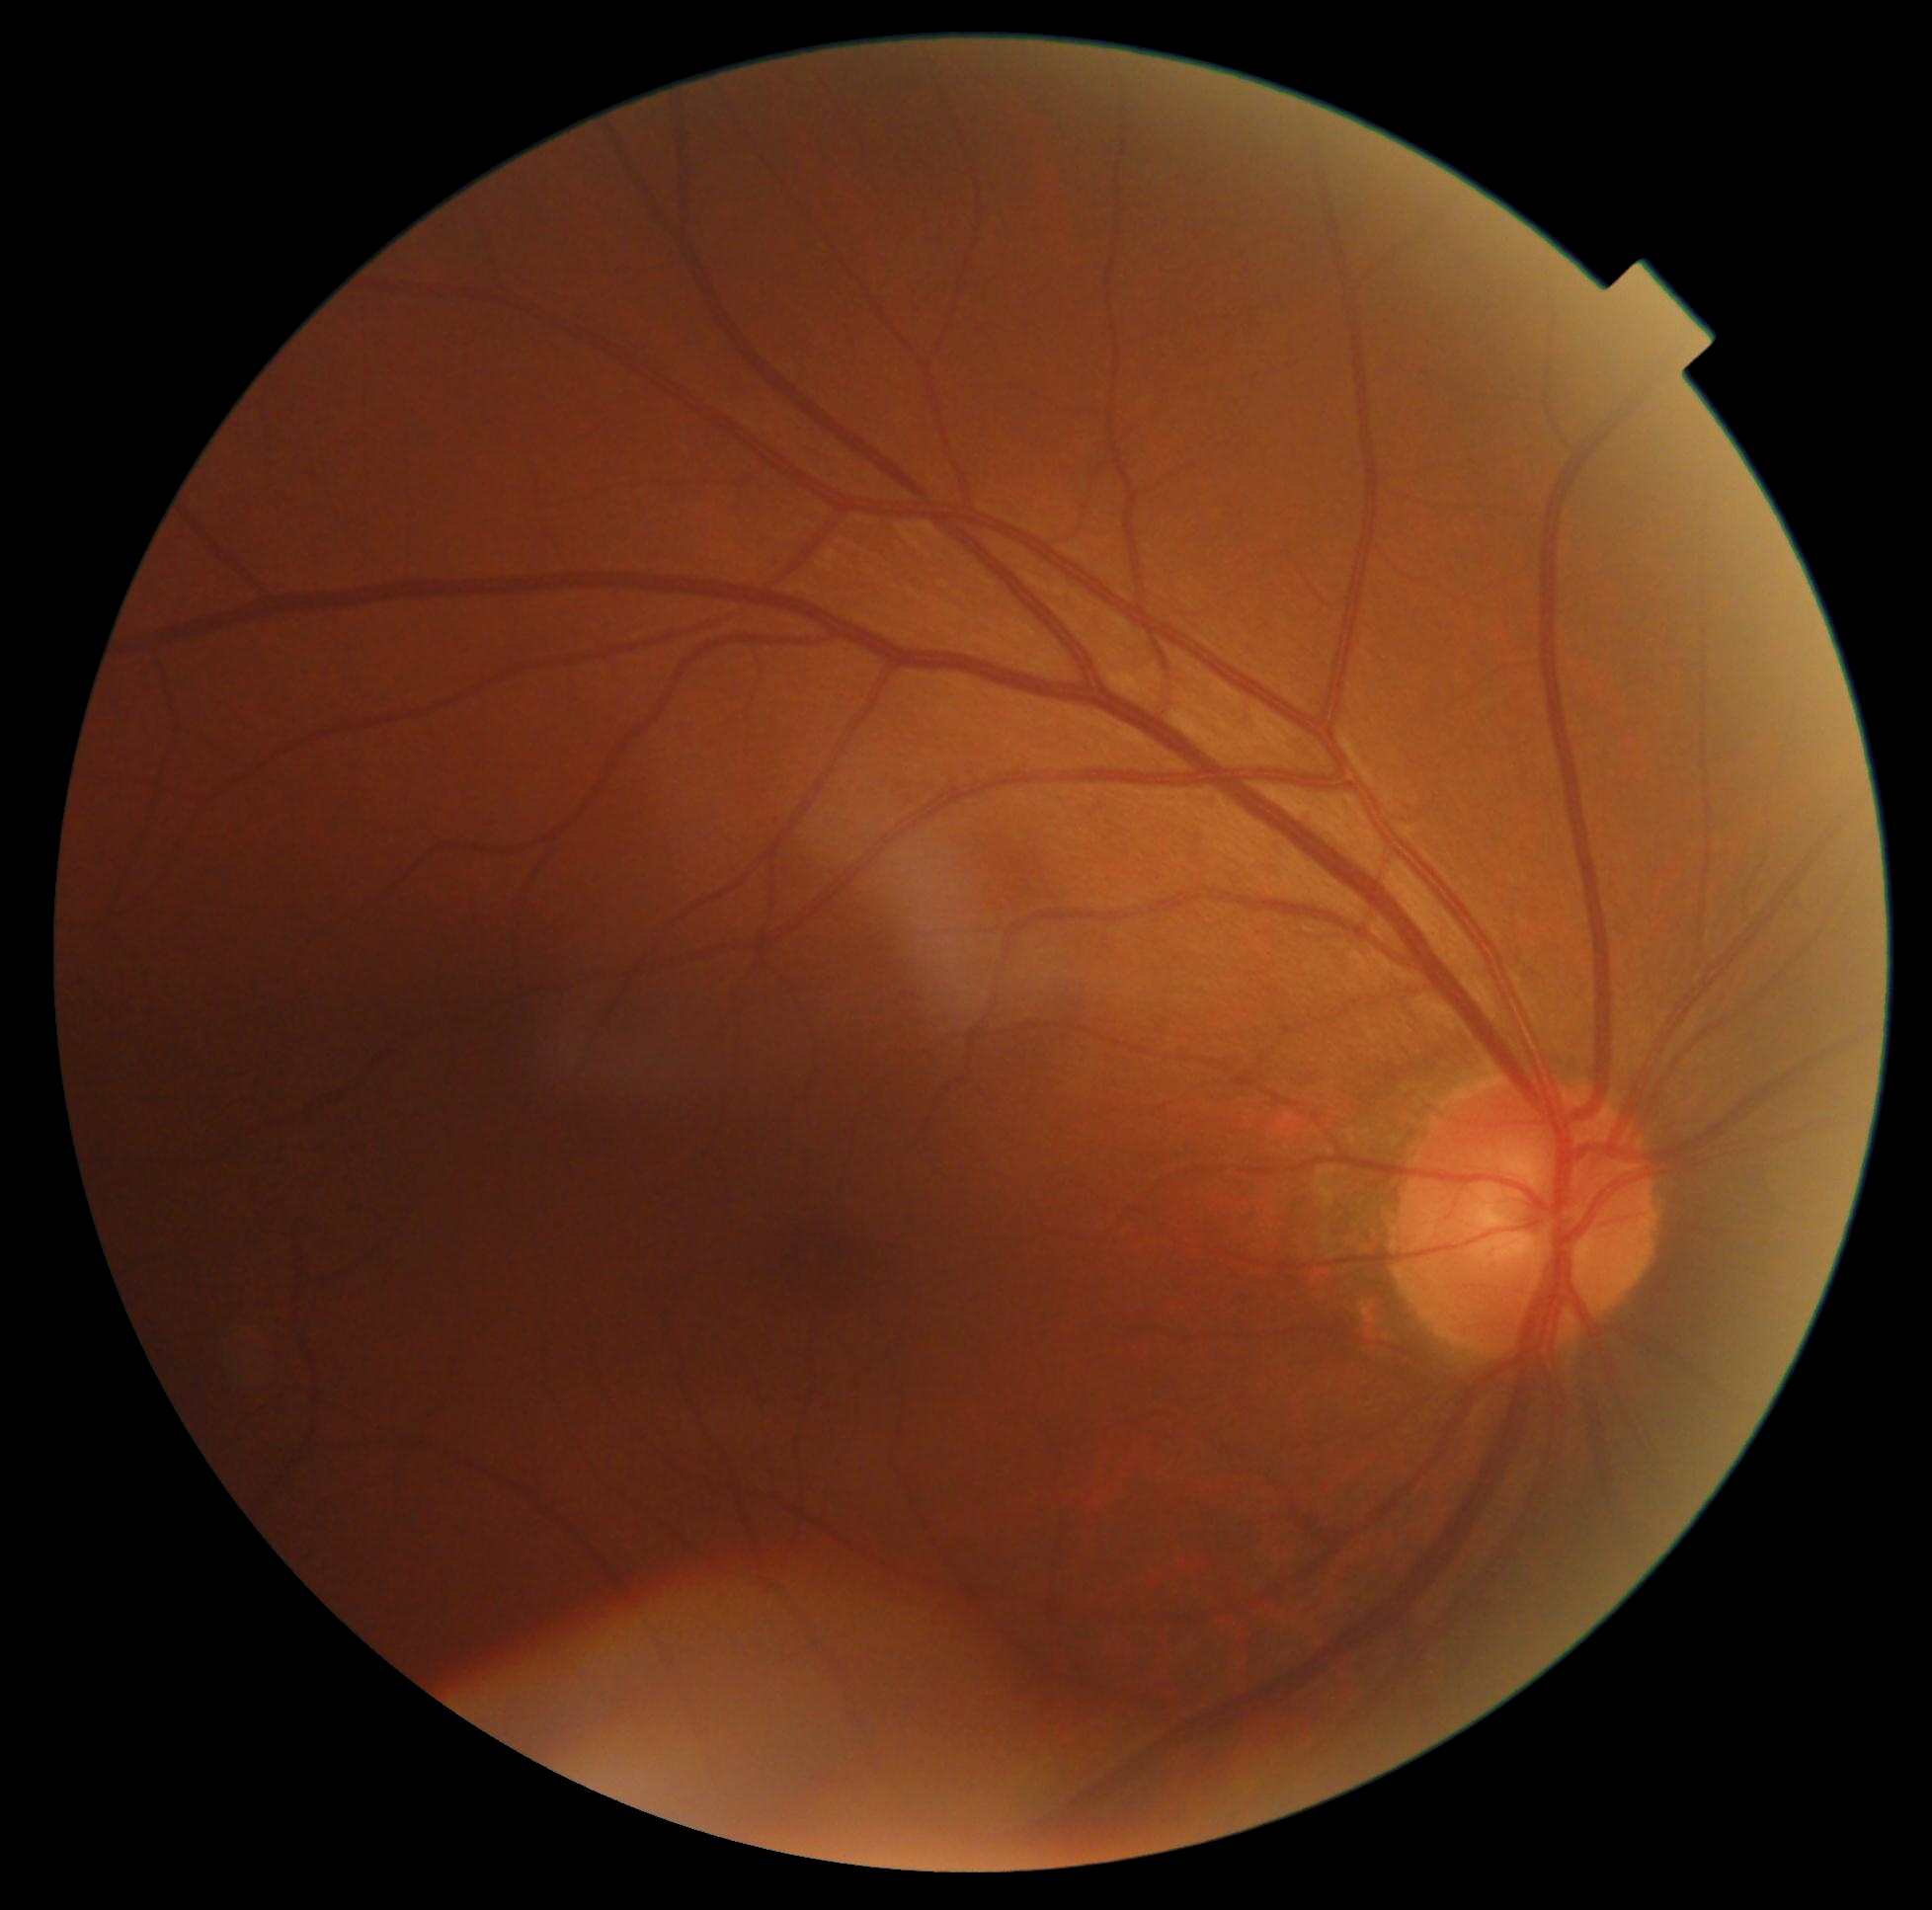 Findings:
– DR impression — no apparent DR
– DR stage — grade 0 (no apparent retinopathy) — no visible signs of diabetic retinopathy